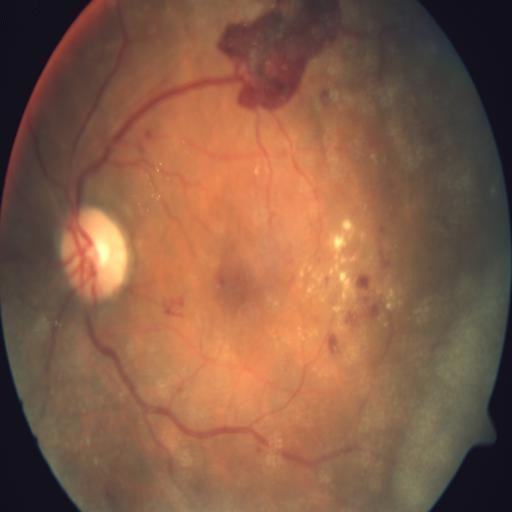
Fundus image with findings of PRH (preretinal hemorrhage), HR (hemorrhagic retinopathy), EDN (exudation) & CWS (cotton wool spots).